848 by 848 pixels; DR severity per modified Davis staging; nonmydriatic; 45° field of view.
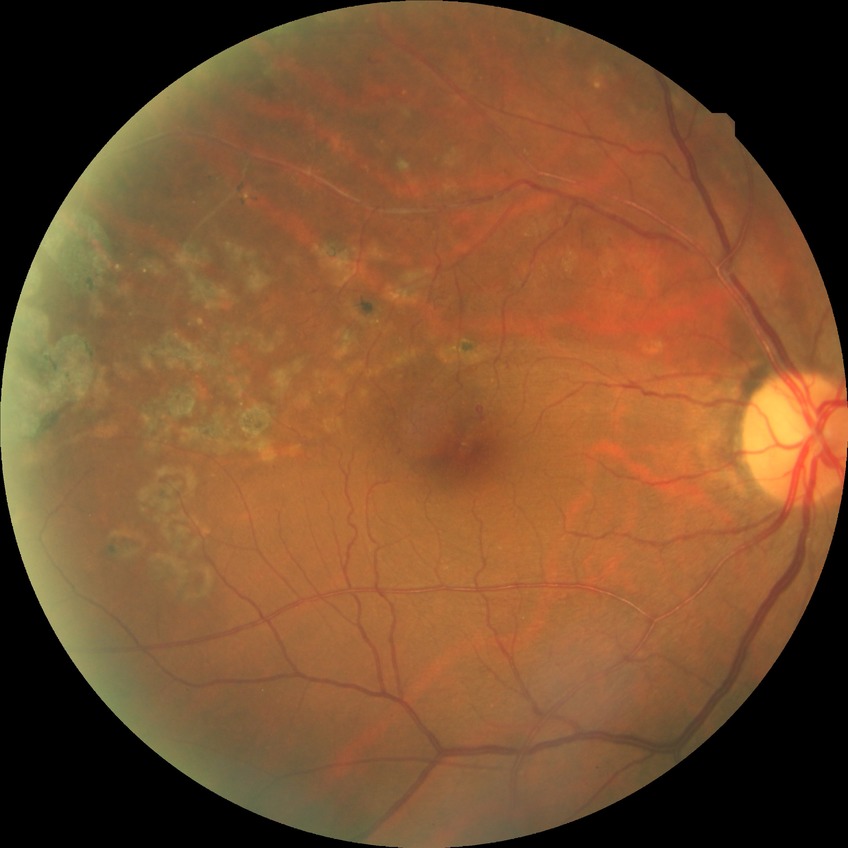
davis_grade: NDR (no diabetic retinopathy)